Color fundus photograph. Field includes the optic disc and macula. Mydriatic (tropicamide and phenylephrine). Image size 2228x1652. 50° field of view — 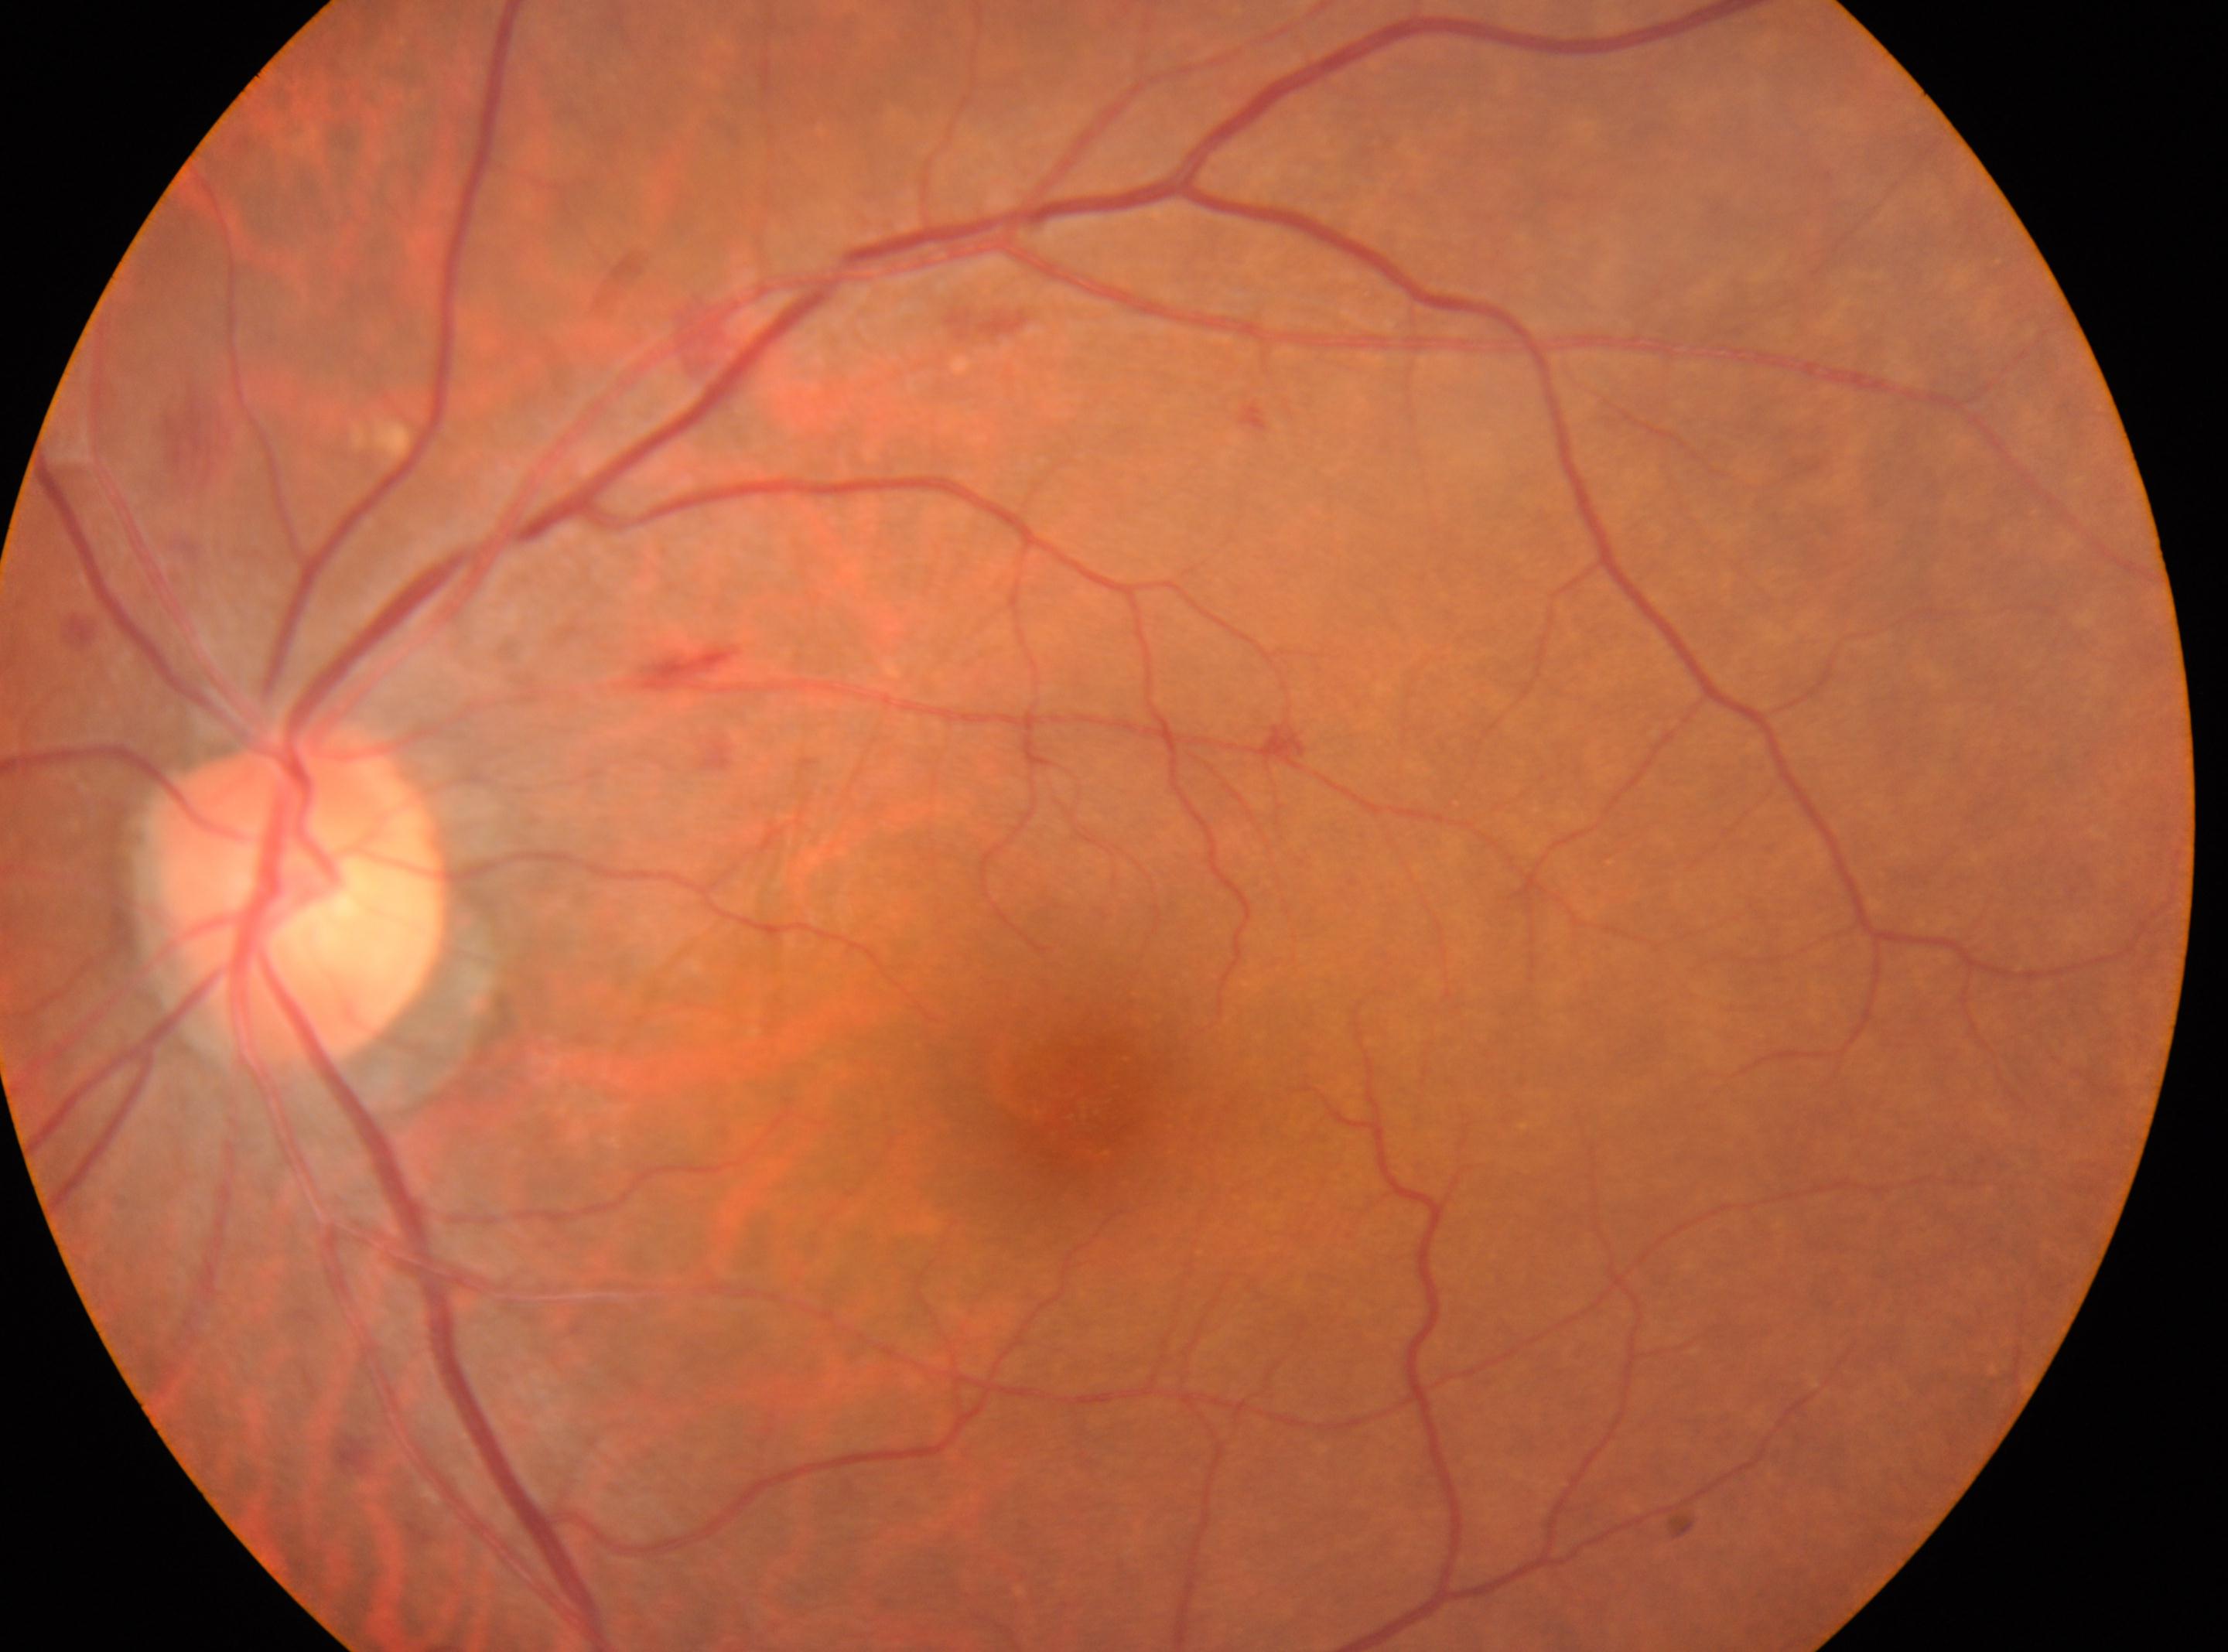 This is the left eye. The disc center is at (299,894). Diabetic retinopathy: moderate NPDR (grade 2) — more than just microaneurysms but less than severe NPDR. Fovea: (1071,1112).